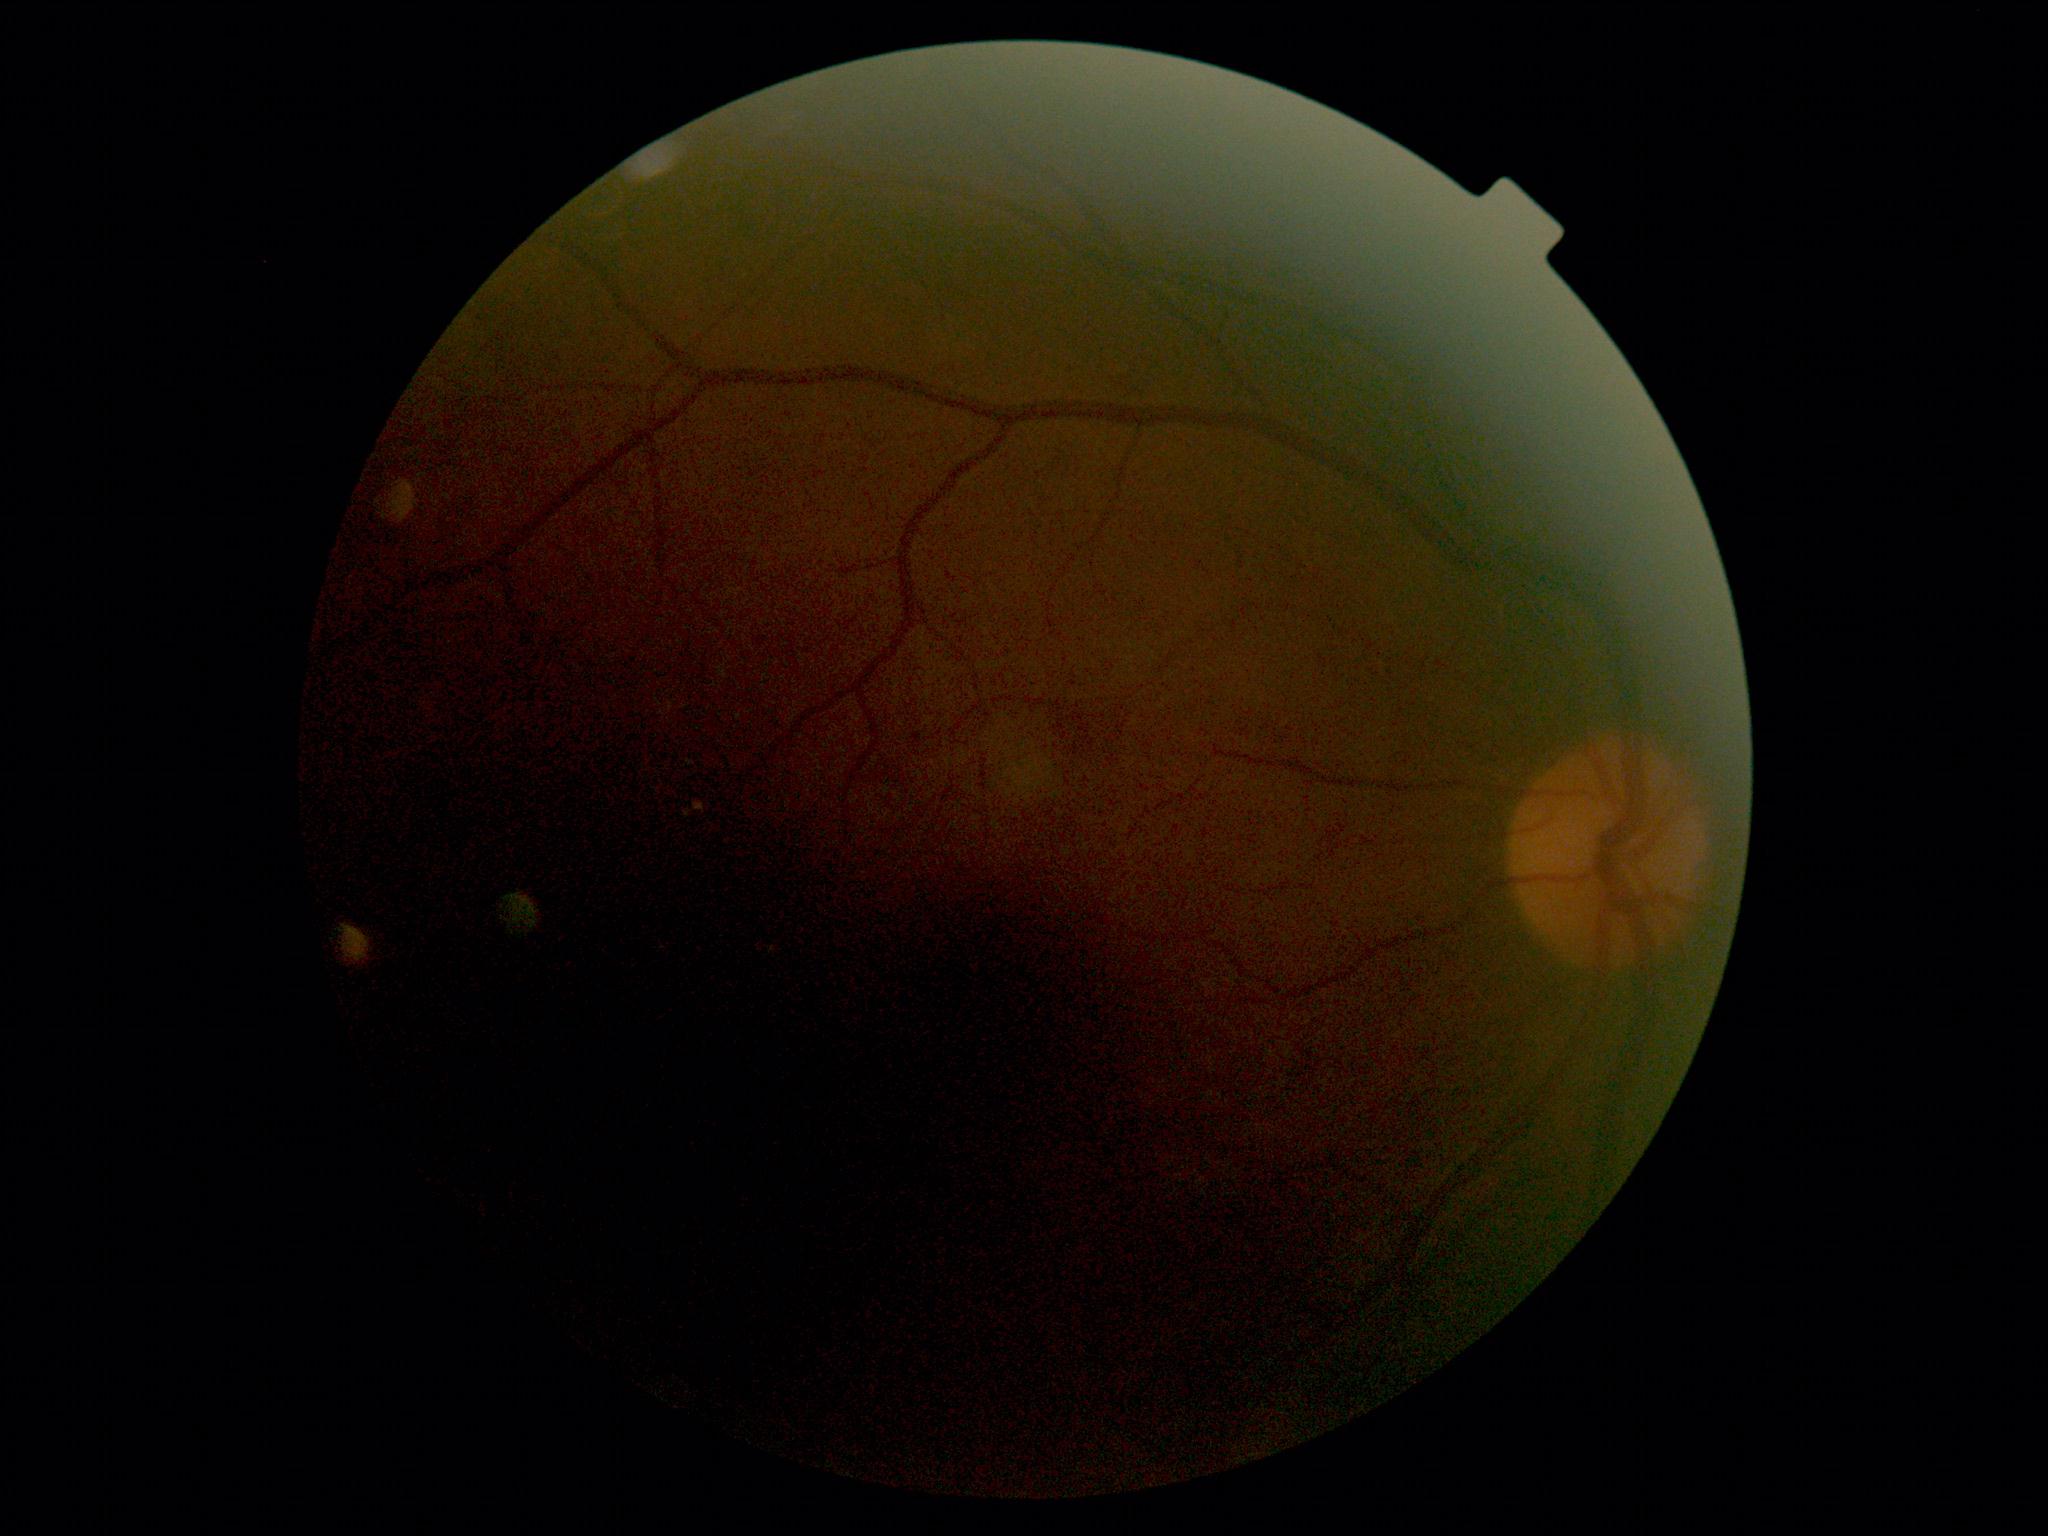

Annotations:
- DR grade — ungradable due to poor image quality